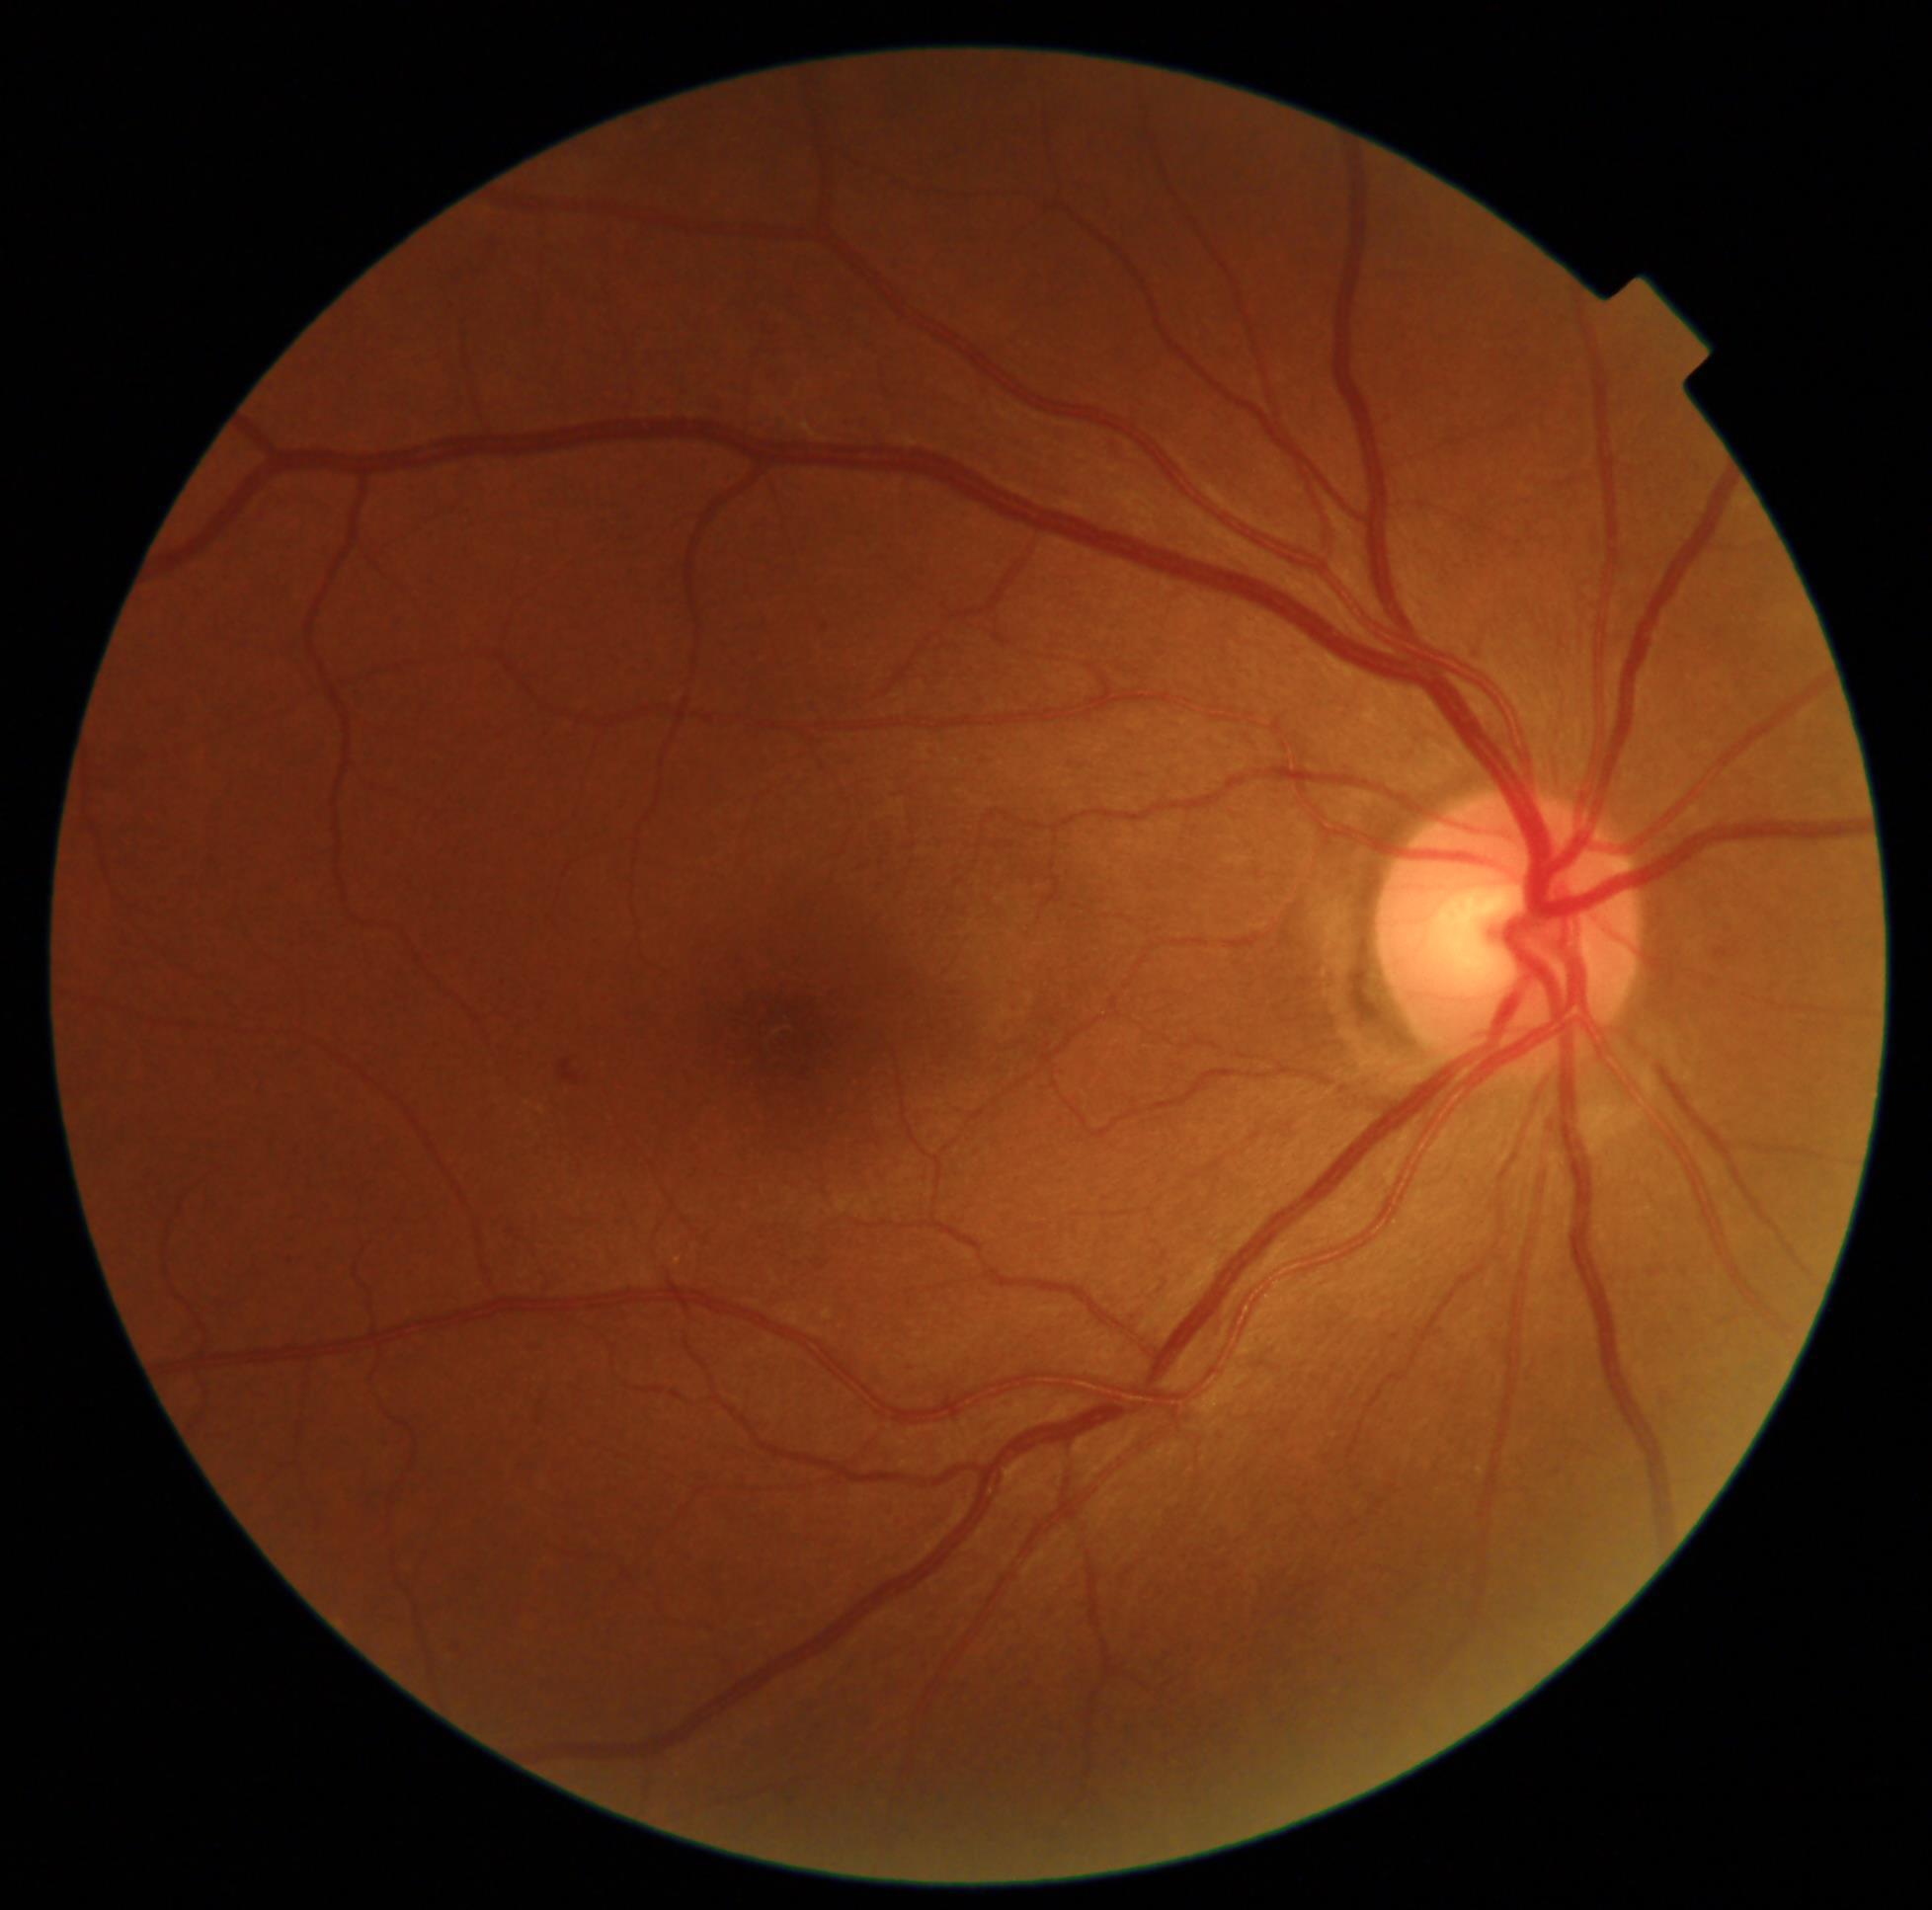 DR class: non-proliferative diabetic retinopathy; DR grade: 2 (moderate NPDR) — more than just microaneurysms but less than severe NPDR.